Wide-field fundus photograph from neonatal ROP screening · 1440 x 1080 pixels
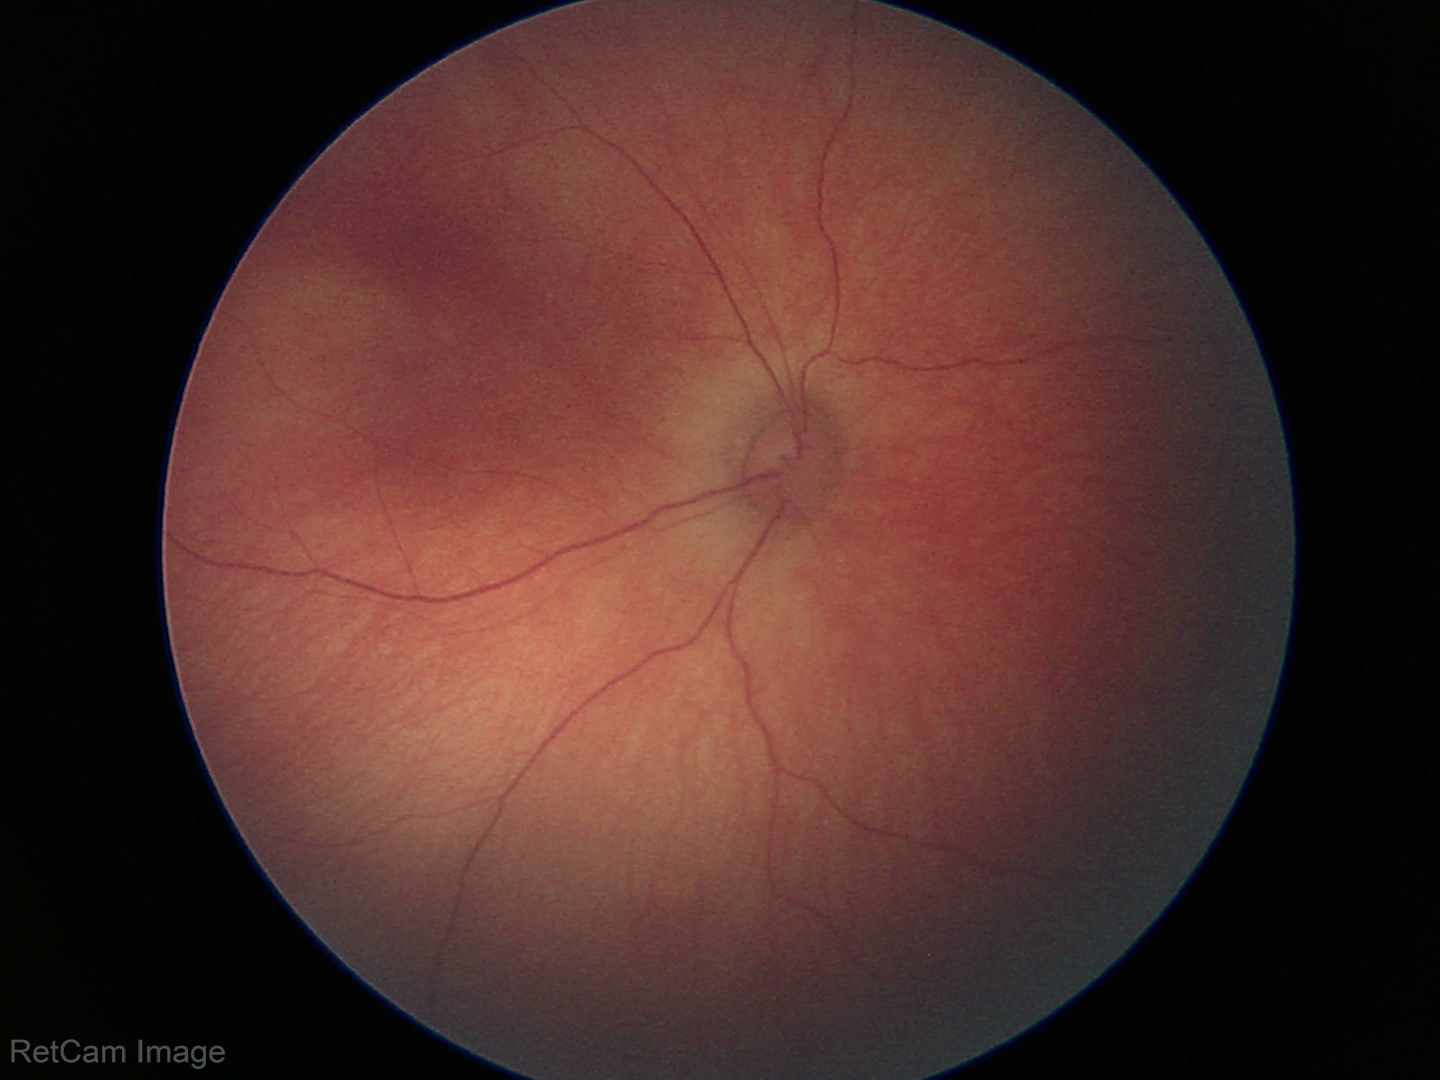
No retinal pathology identified on screening.